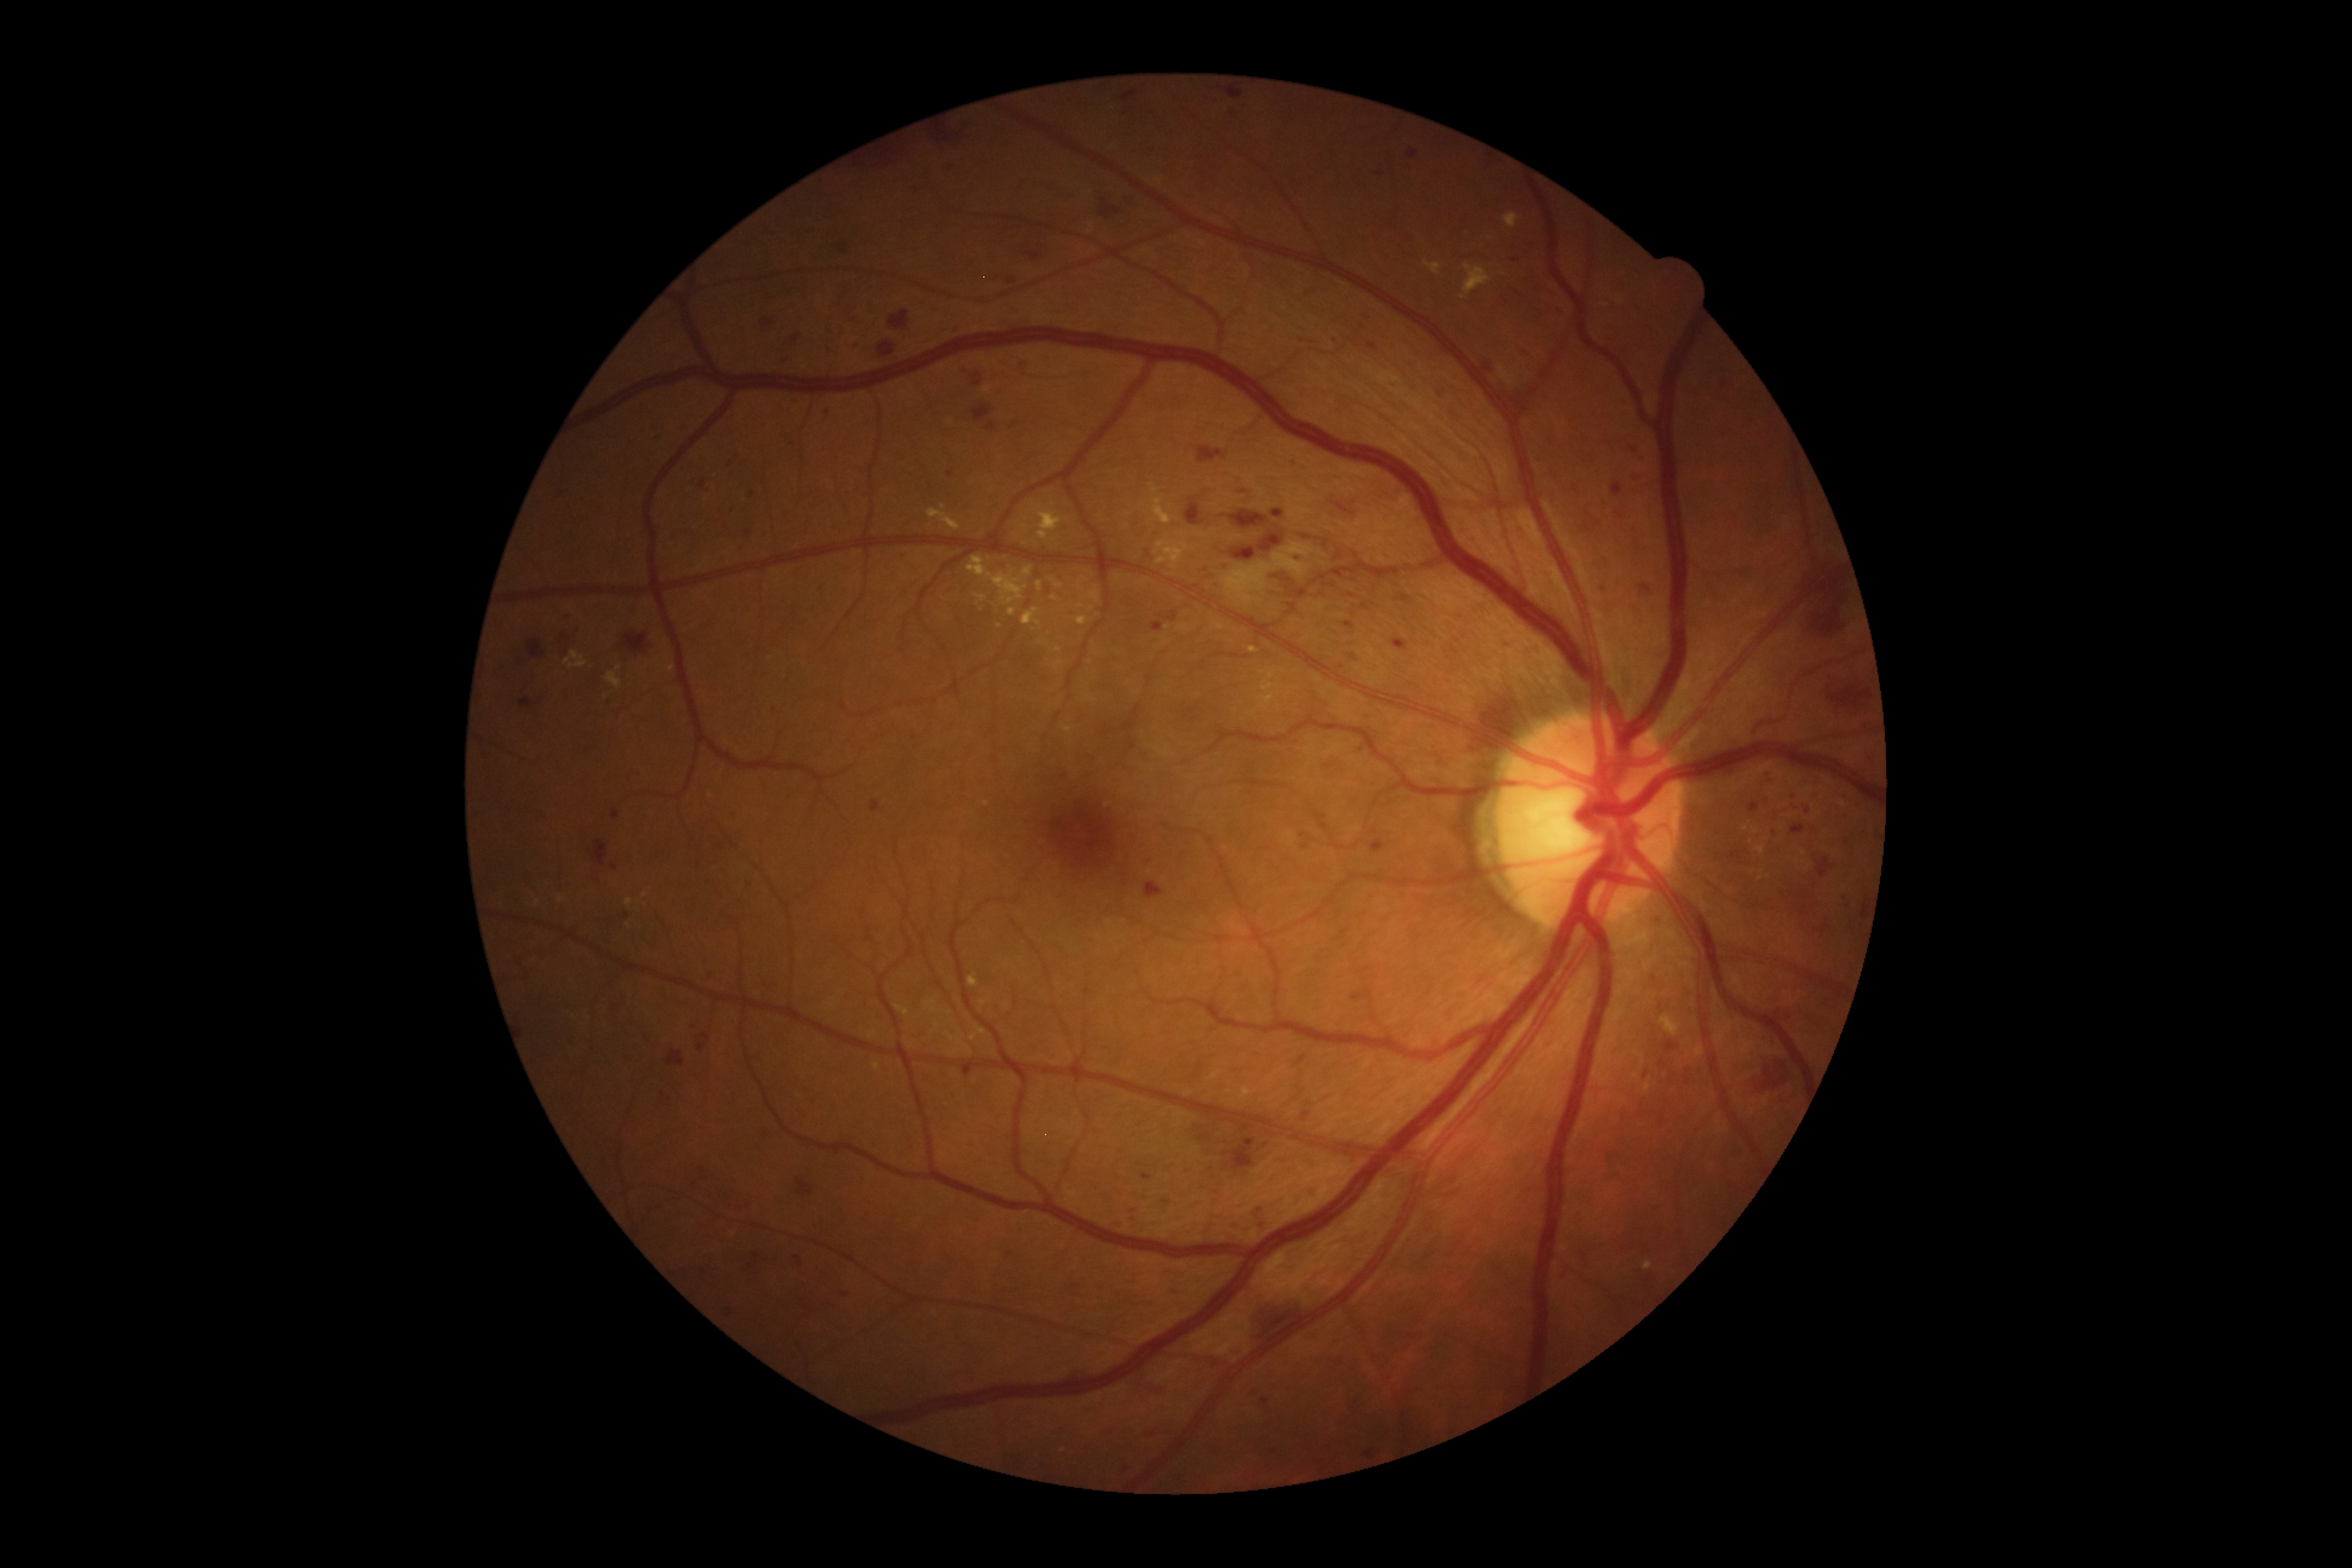
dr_grade: severe NPDR (grade 3)